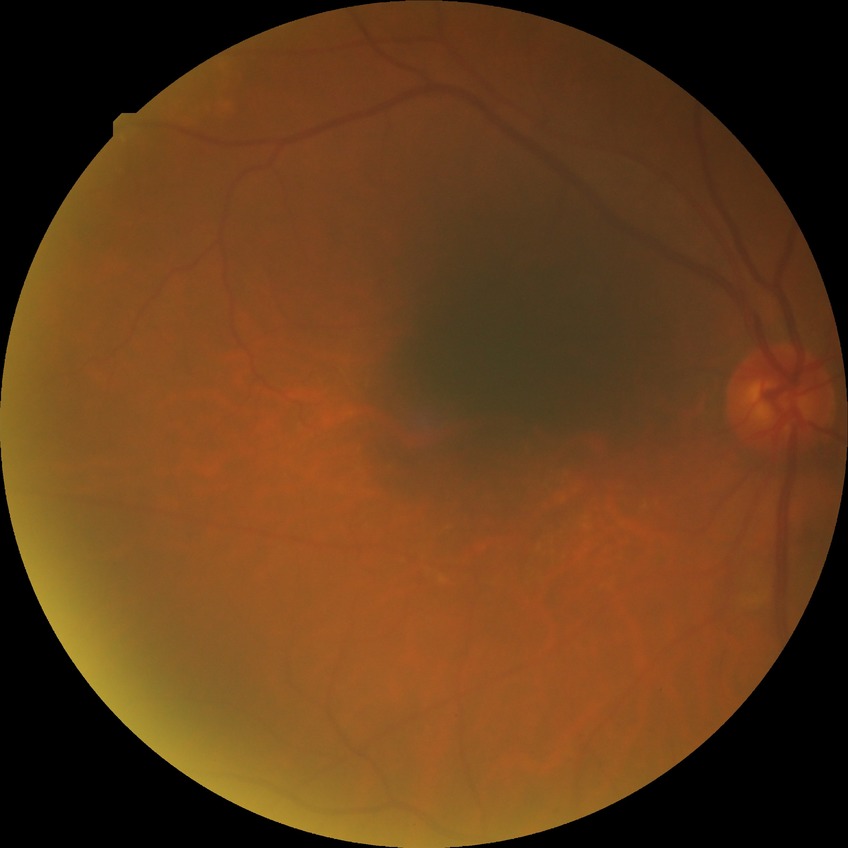

Diabetic retinopathy (DR): SDR (simple diabetic retinopathy).